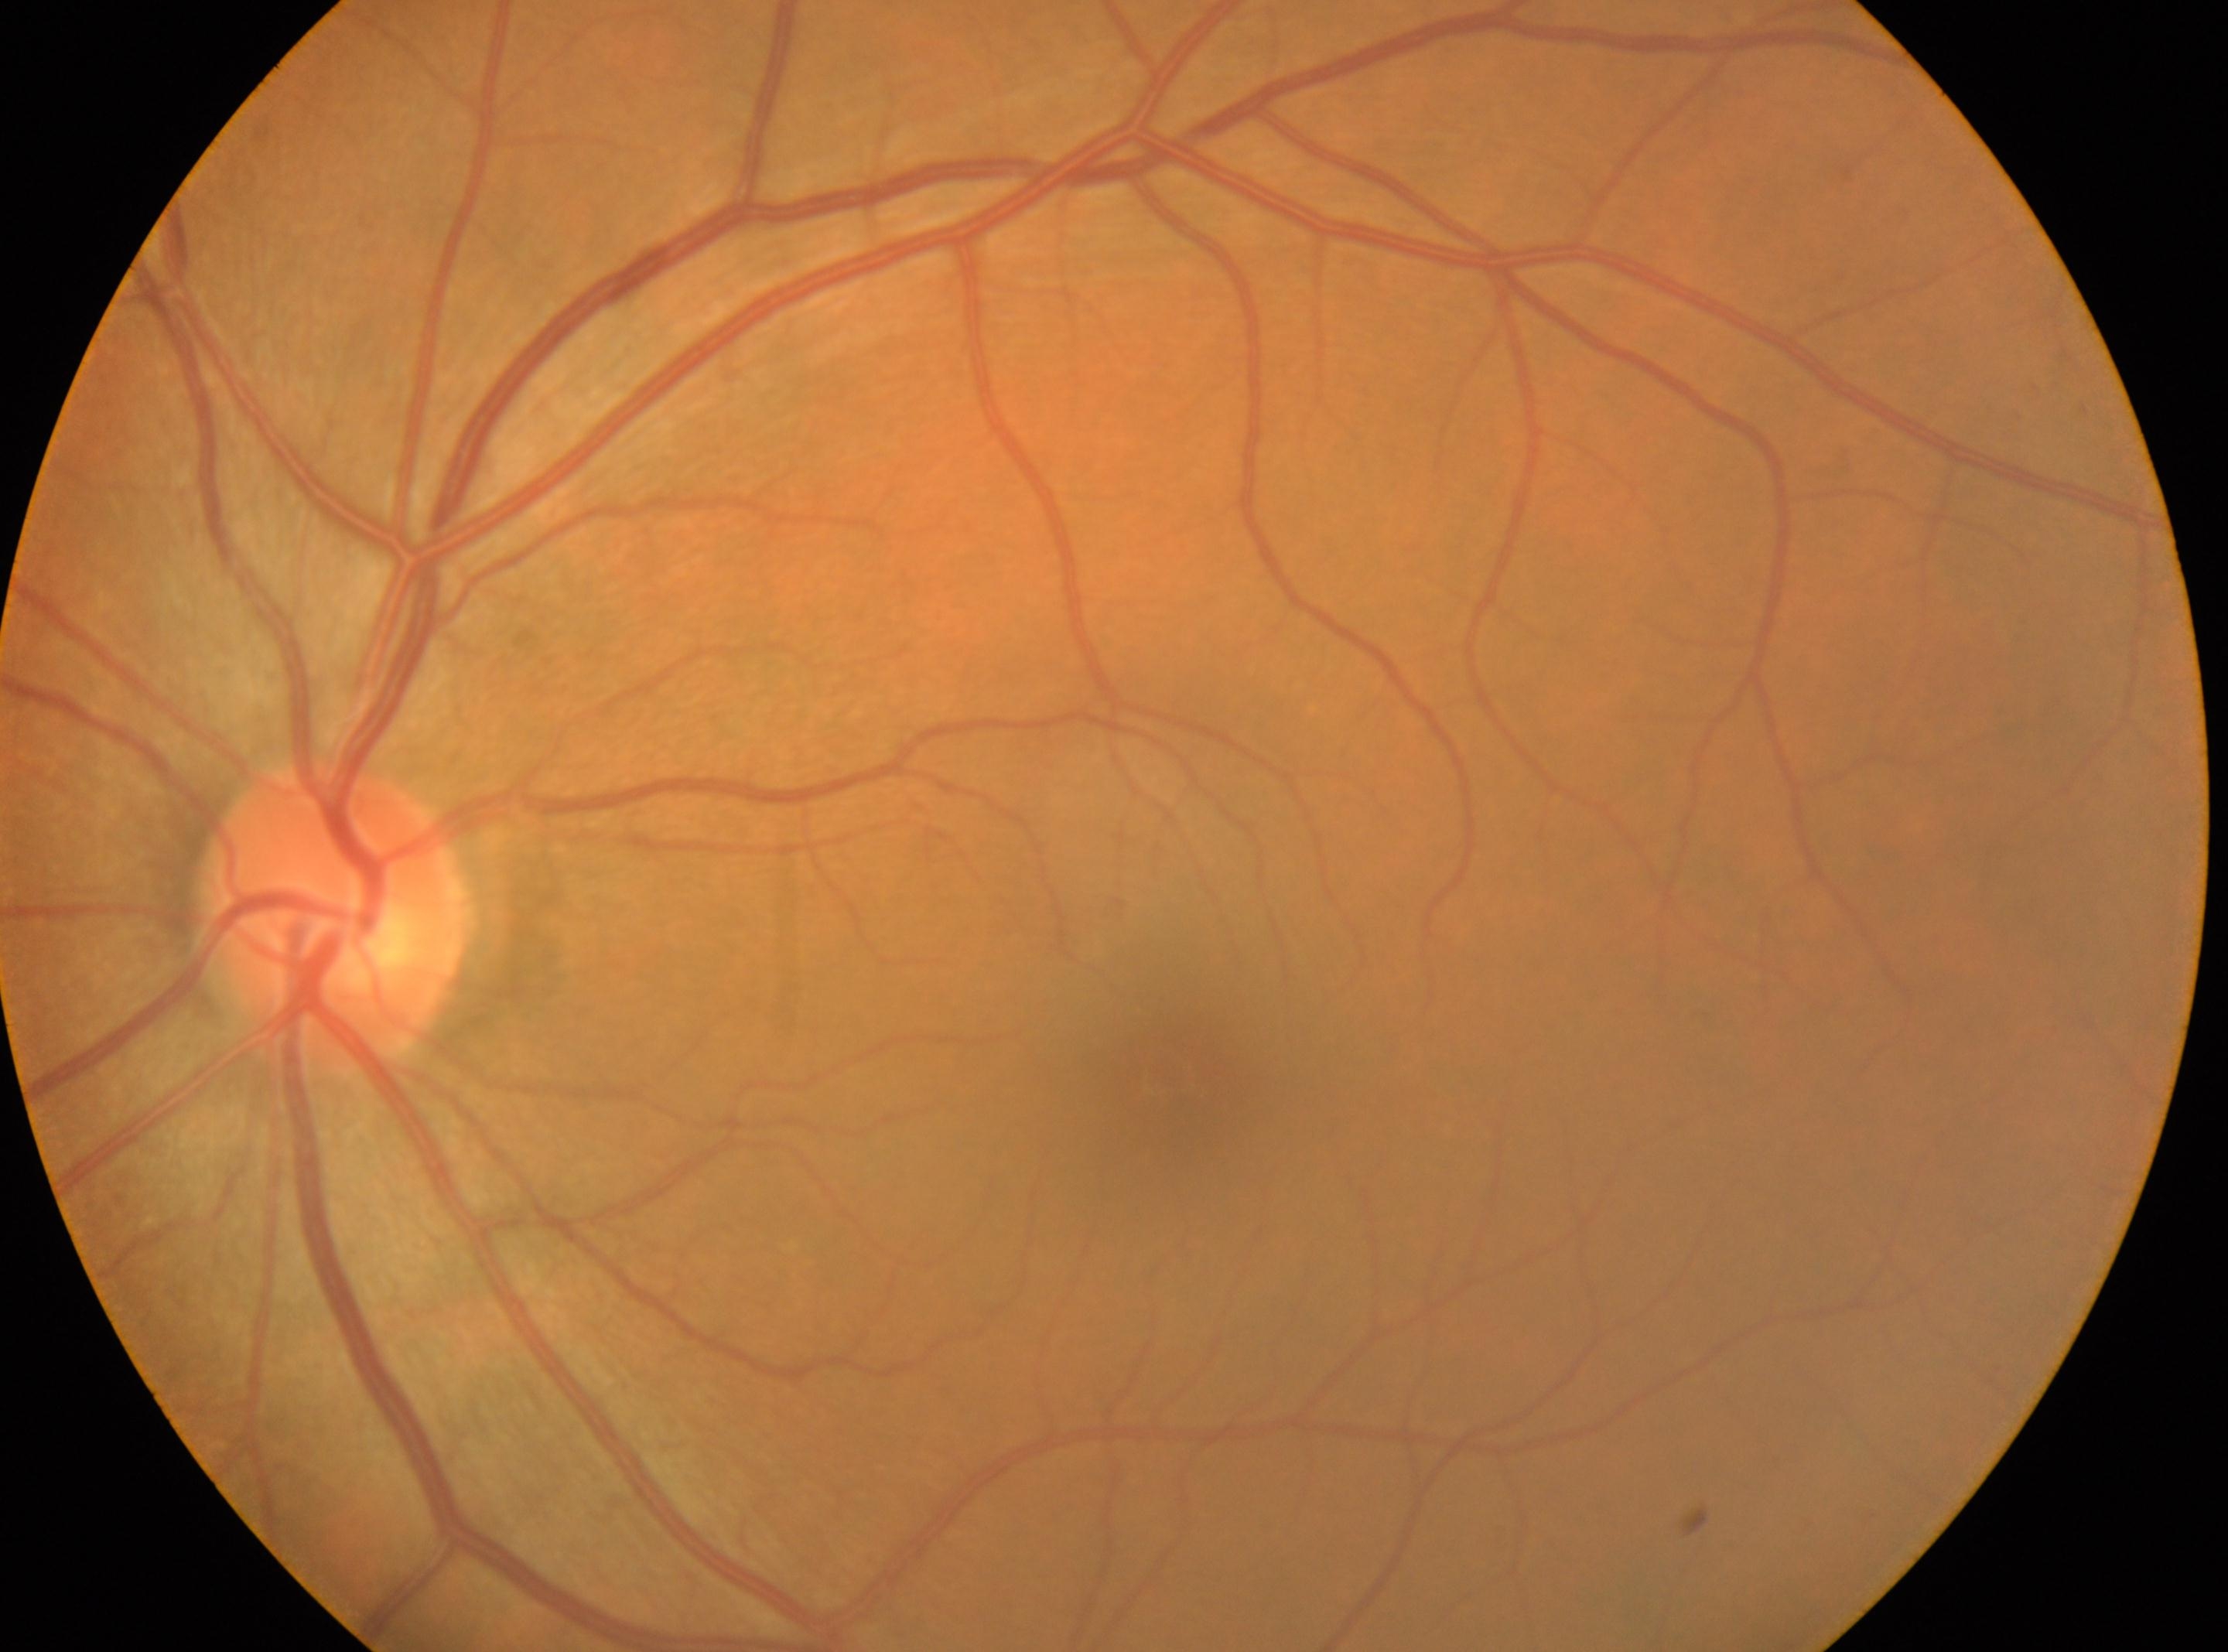

The disc center is at (x: 333, y: 918). No diabetic retinopathy identified. DR stage is grade 0 (no apparent retinopathy). Foveal center: (x: 1176, y: 1073). Imaged eye: left eye.